RetCam wide-field infant fundus image; 640x480px
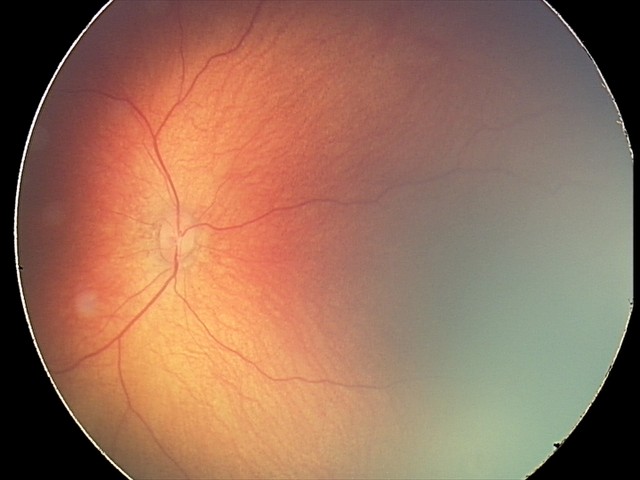
From an examination with diagnosis of retinal hemorrhages.